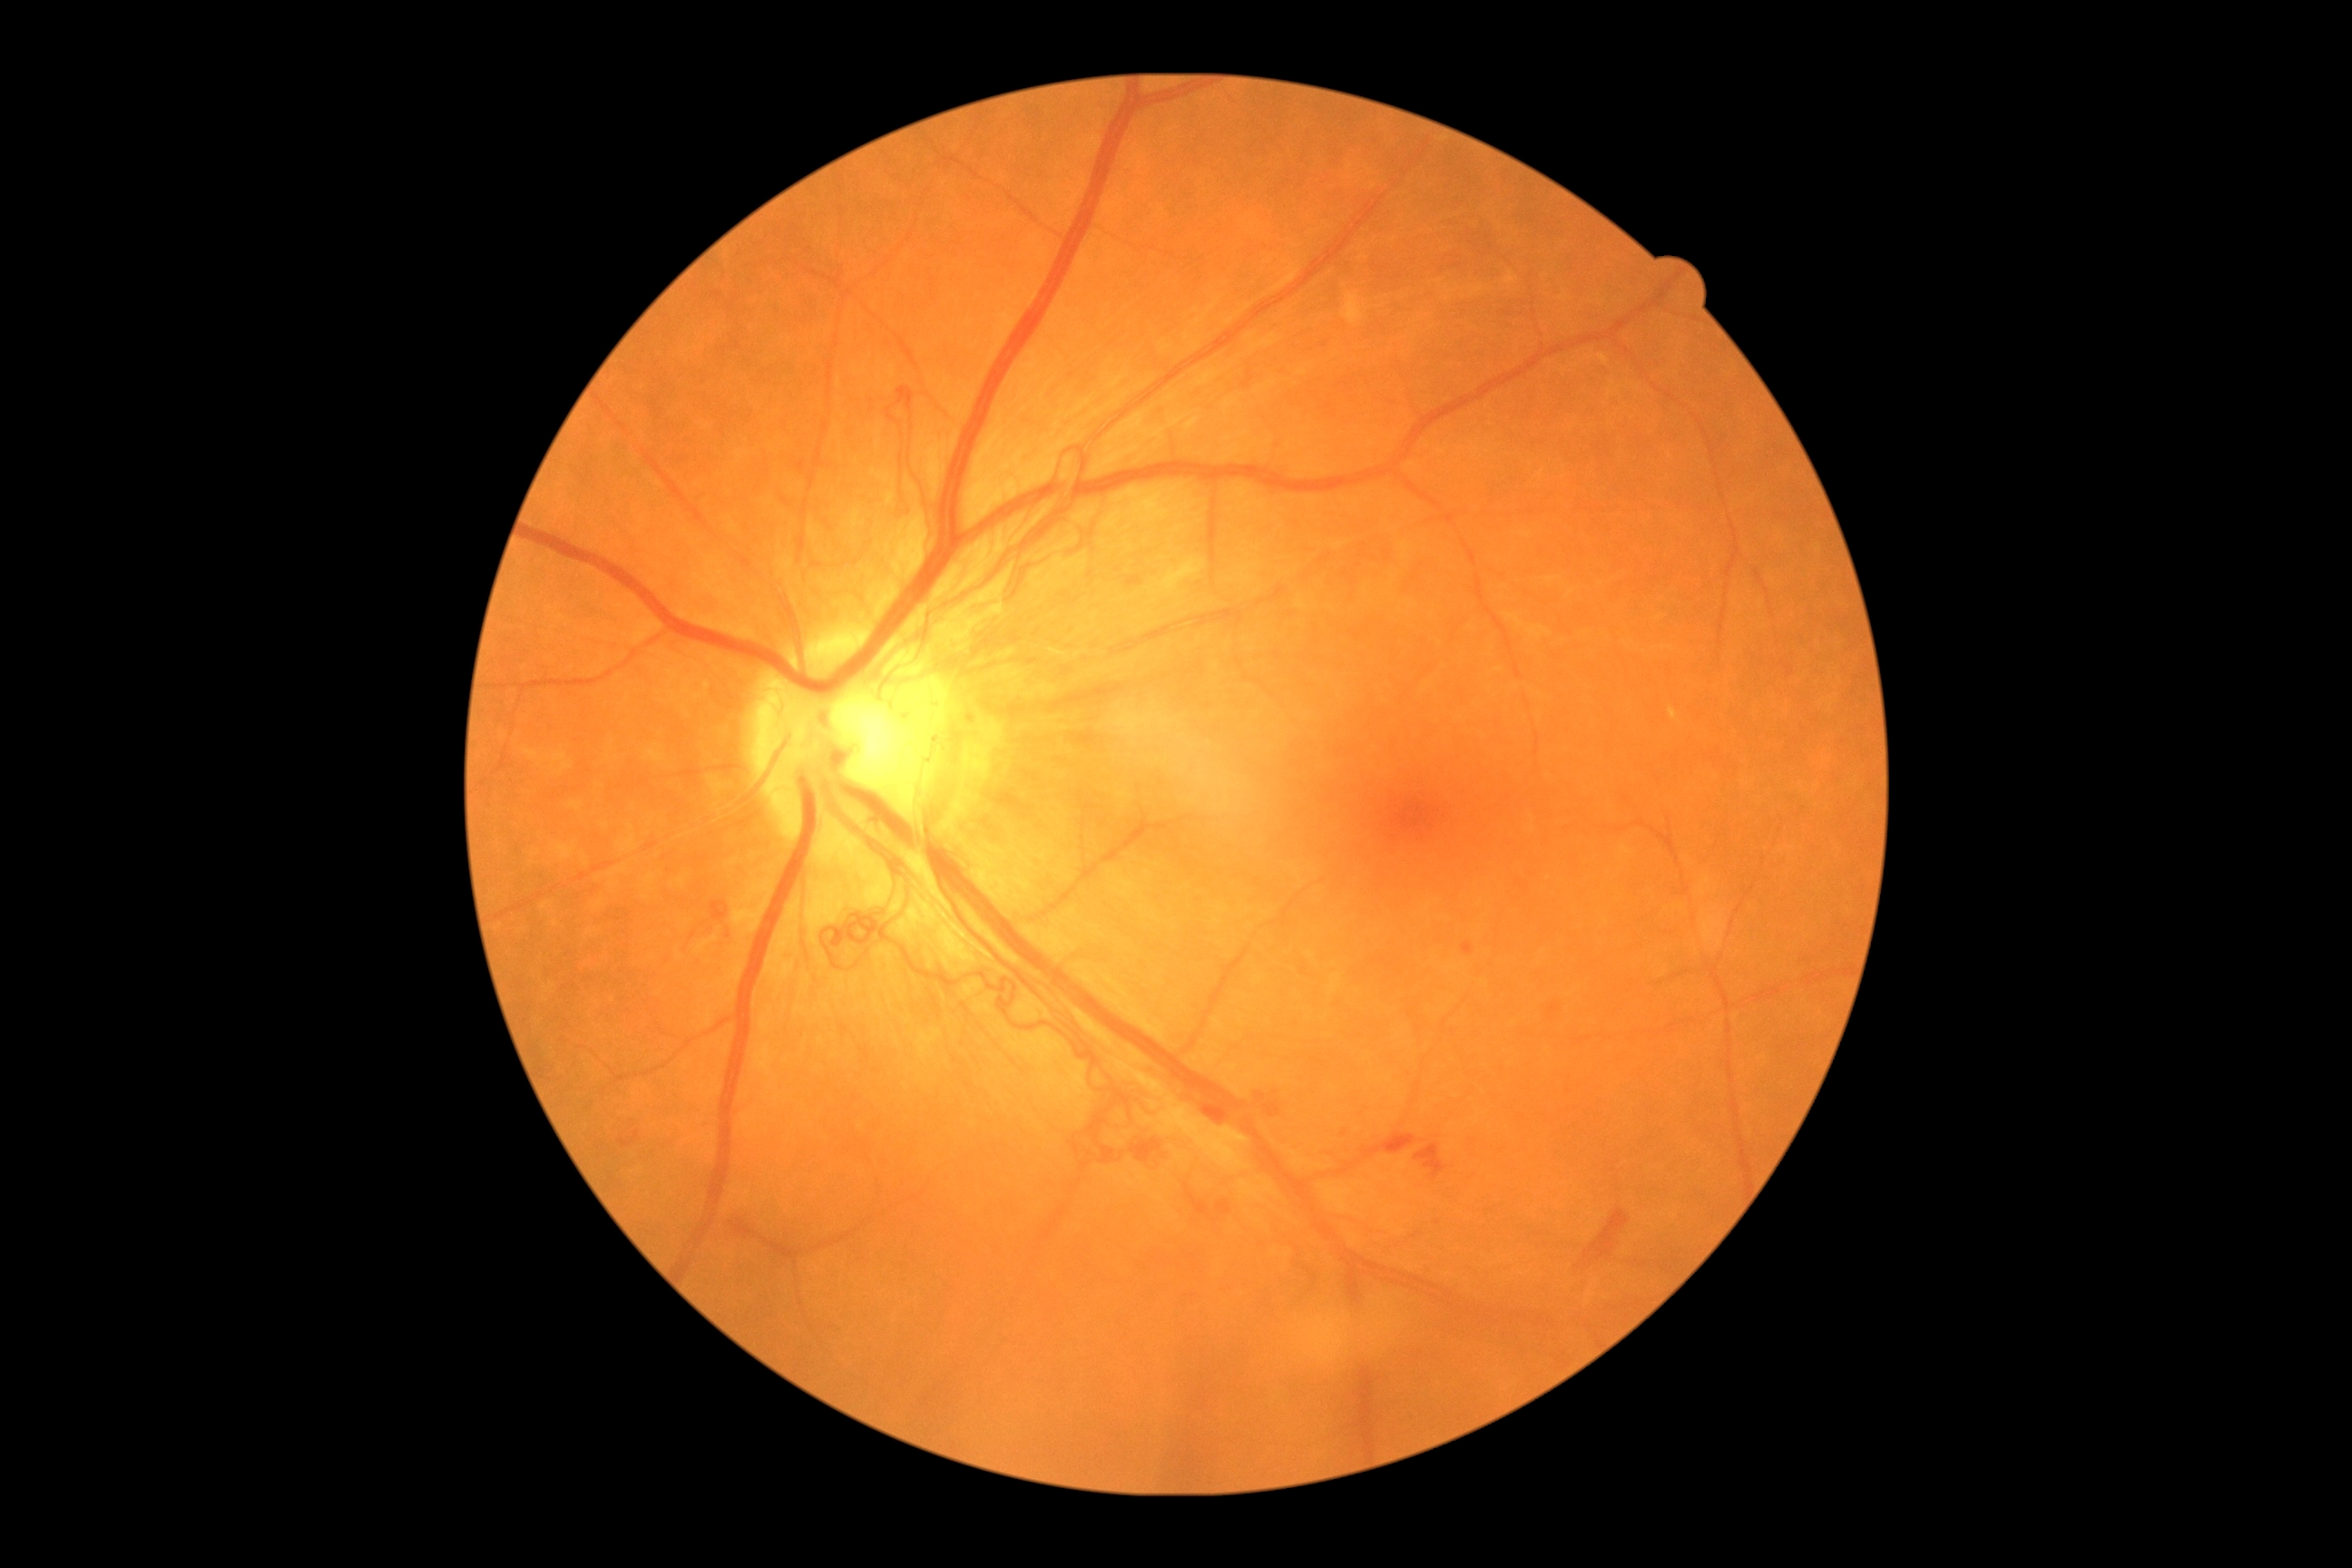
DR severity = proliferative diabetic retinopathy (grade 4).